1932 by 1932 pixels · 45° FOV — 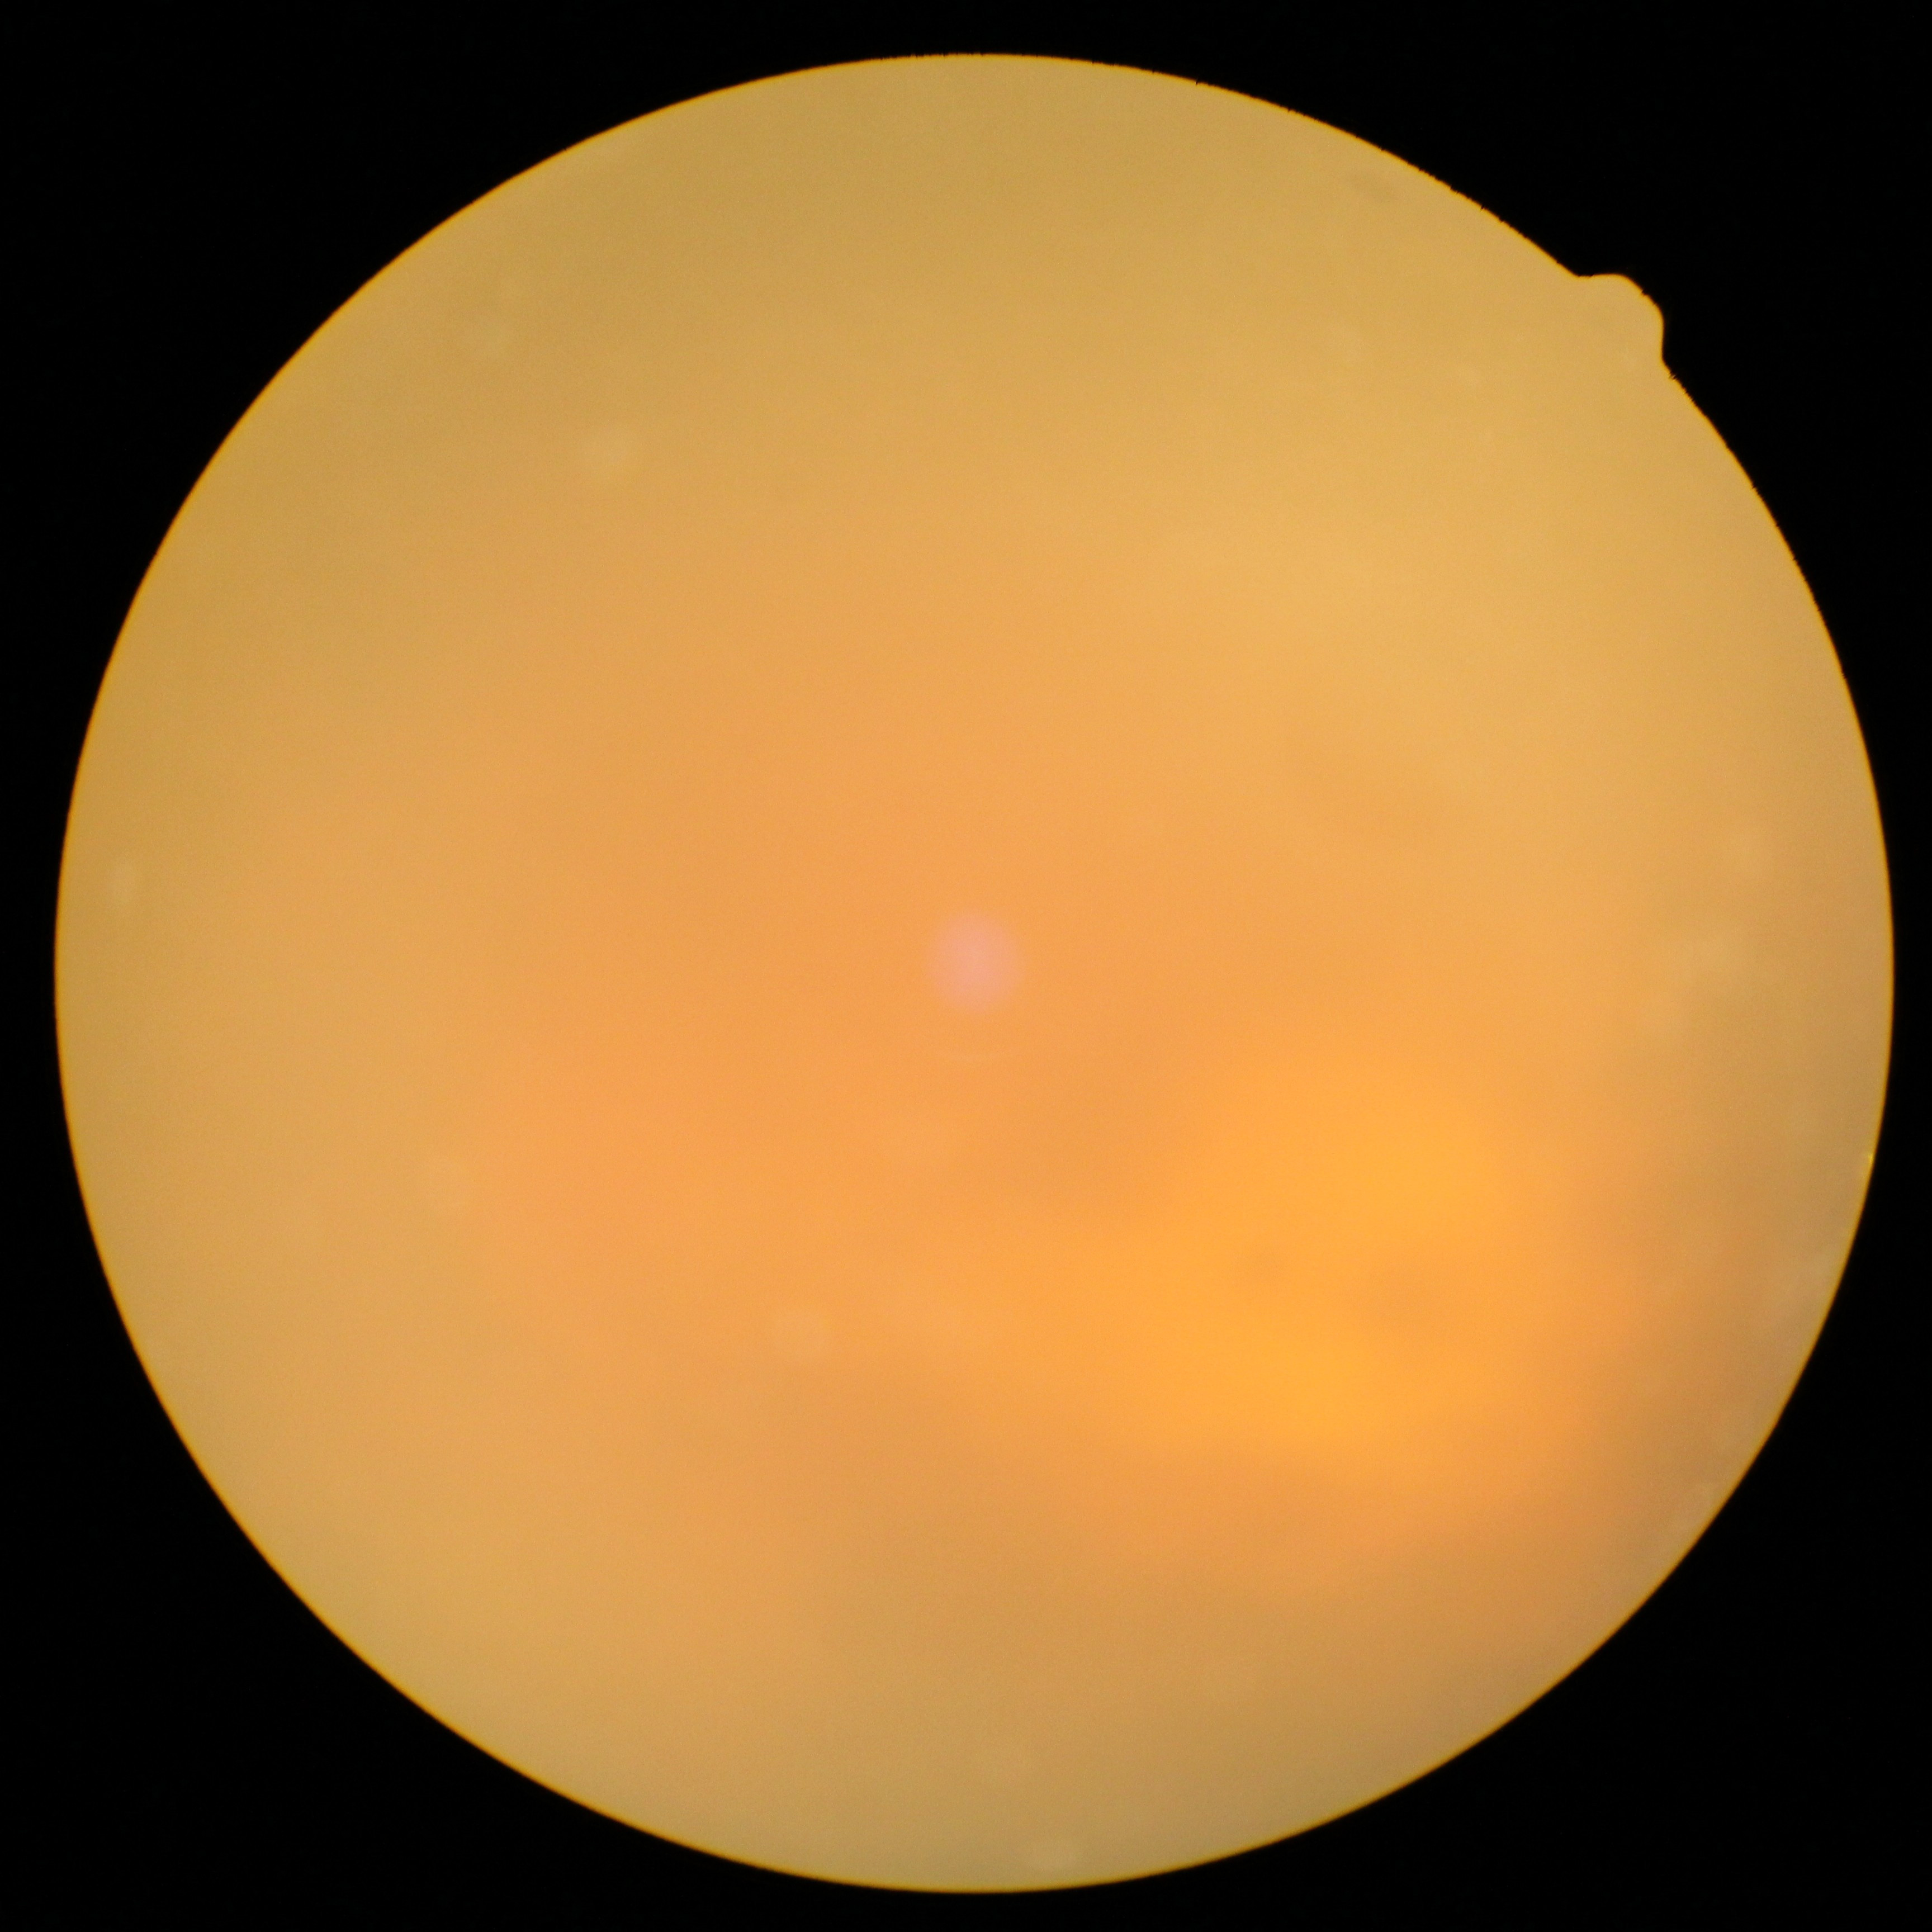

dr_grade: ungradable